Color fundus image, 45° FOV, 1960x1897px:
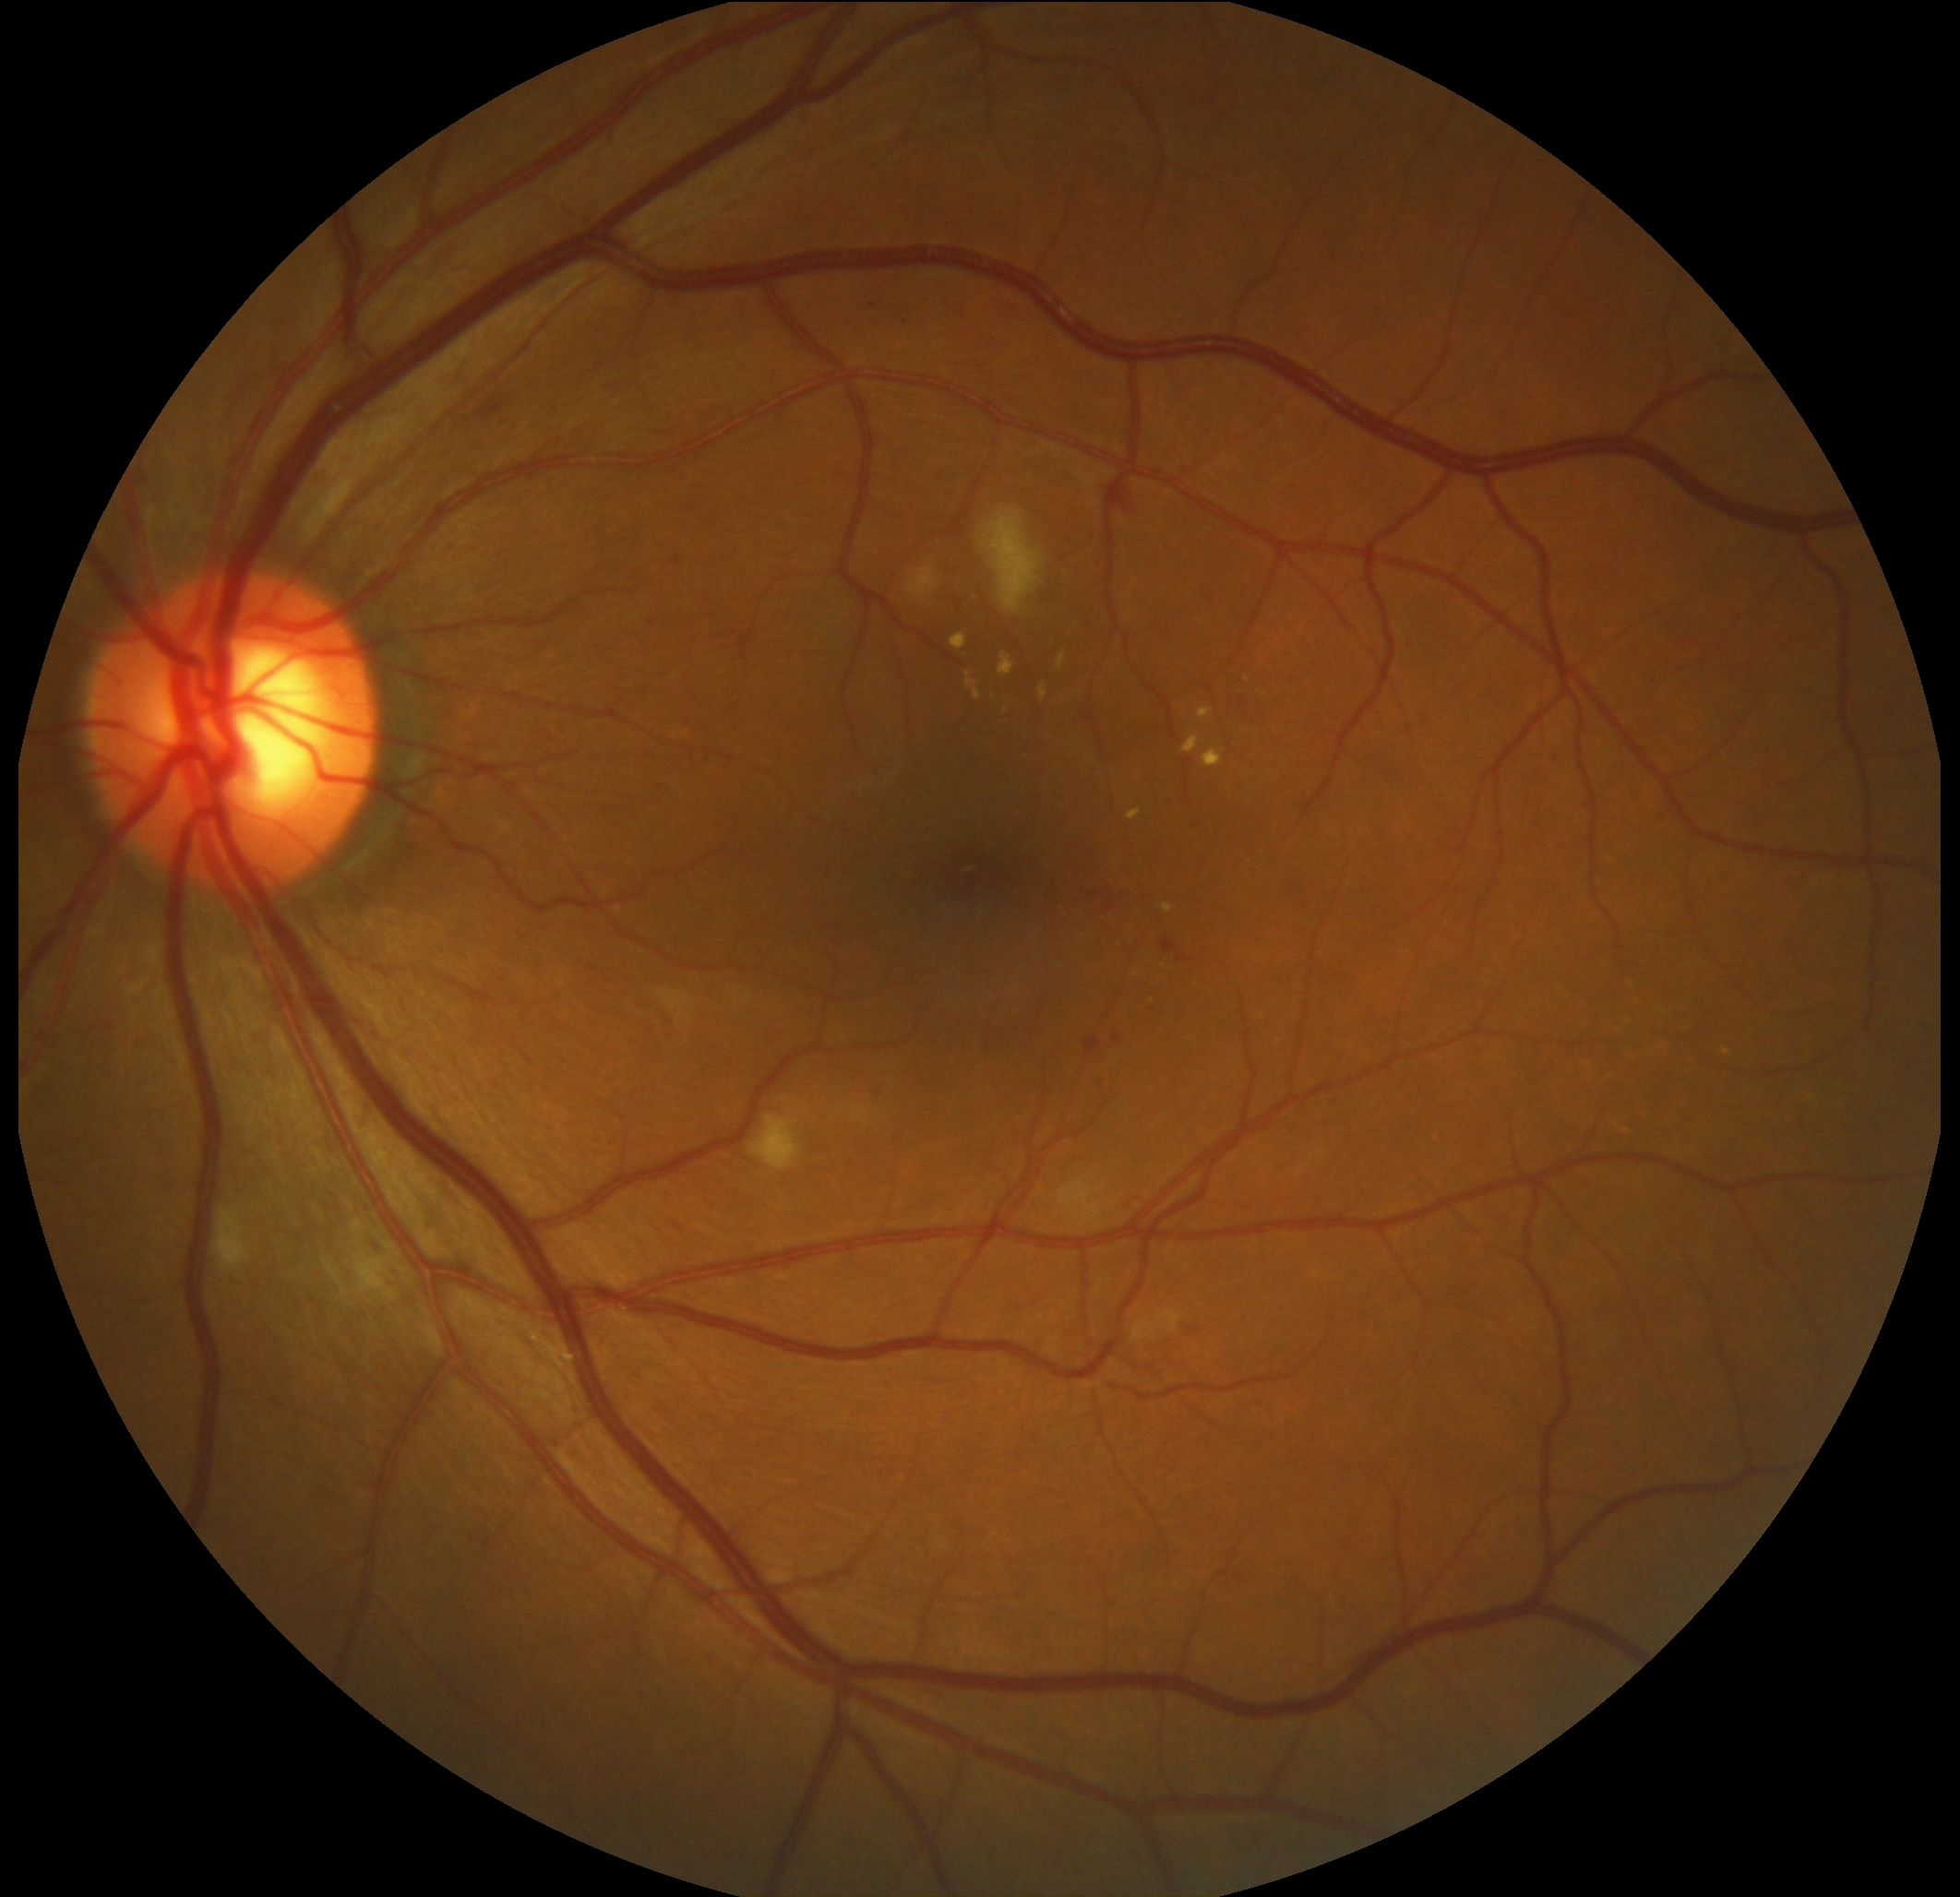
DR grade: 2 (moderate NPDR). DR class: non-proliferative diabetic retinopathy.